RetCam wide-field infant fundus image
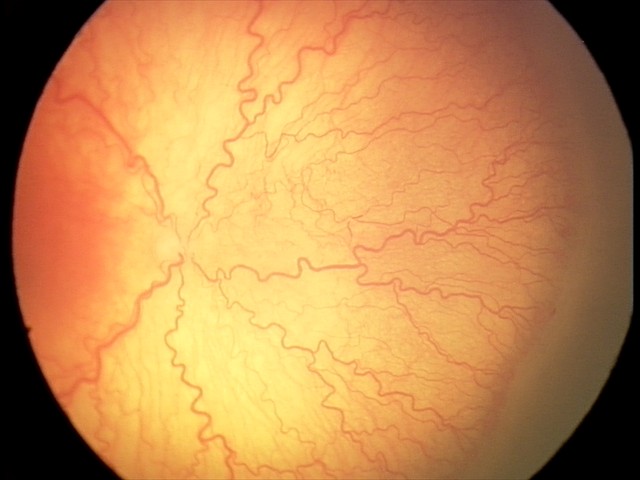
Plus disease: present — abnormal dilation and tortuosity of the posterior pole retinal vessels, finding: aggressive retinopathy of prematurity.